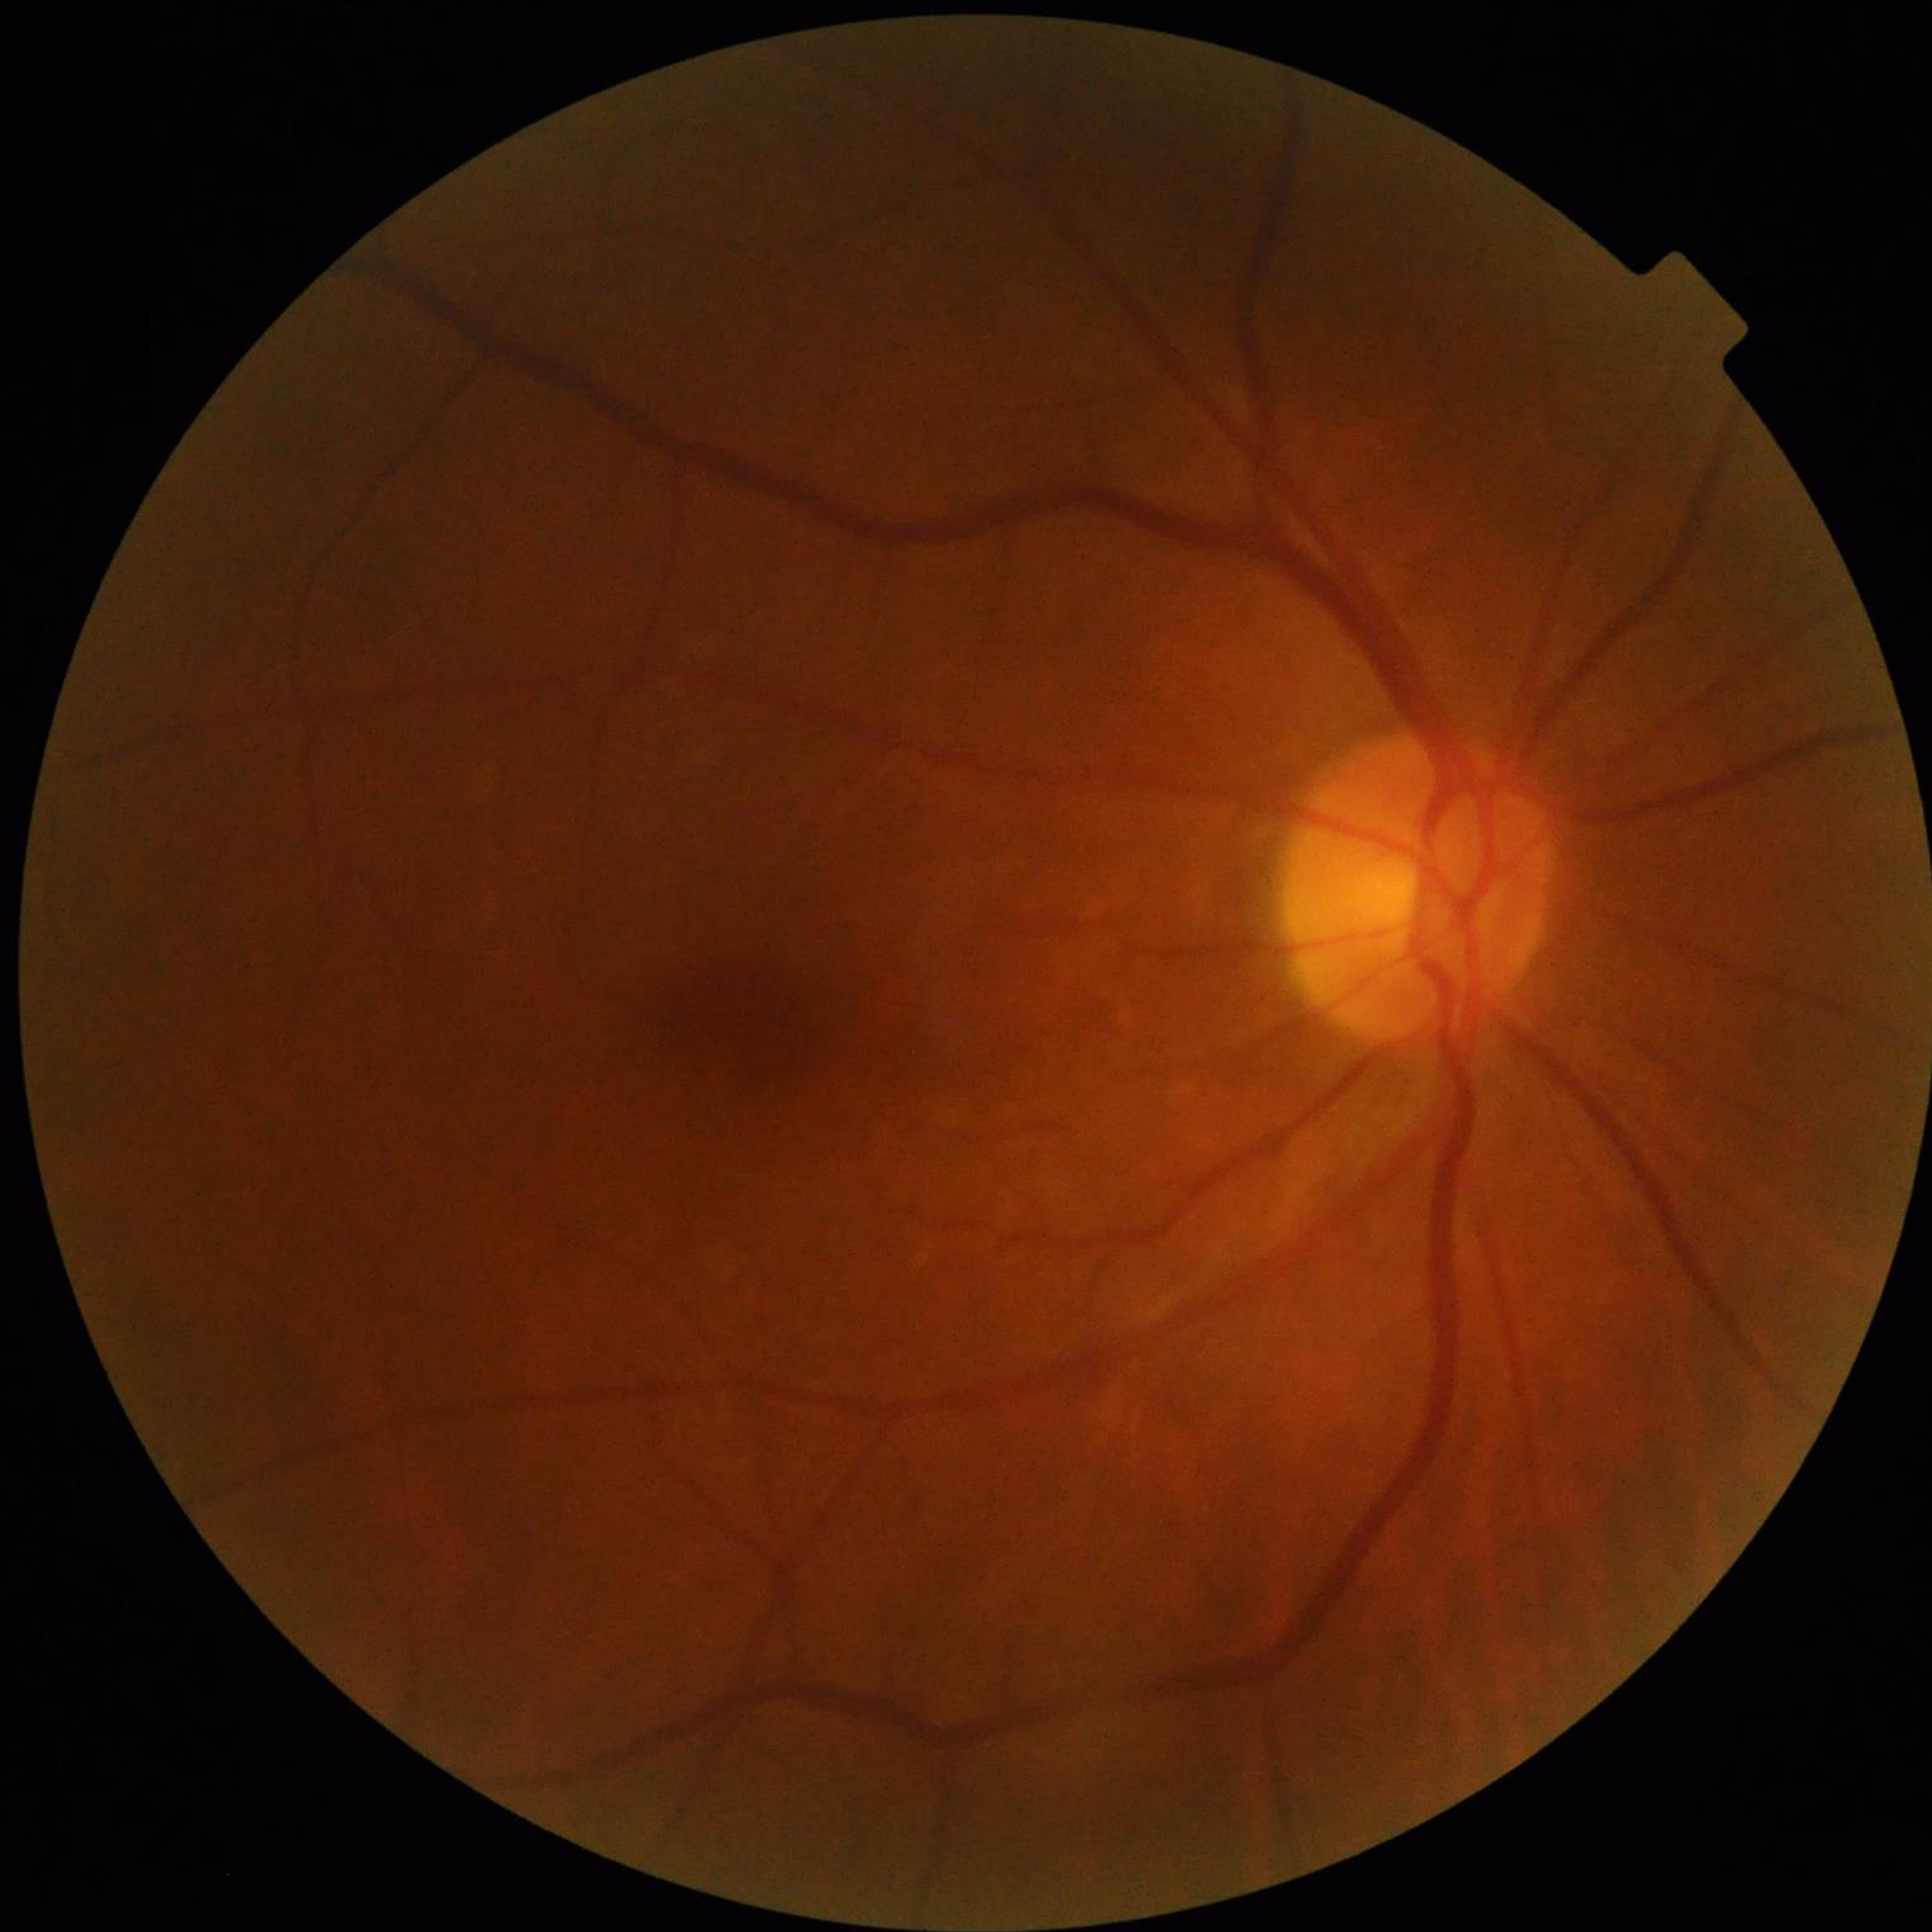

No AMD, DR, or glaucomatous findings.